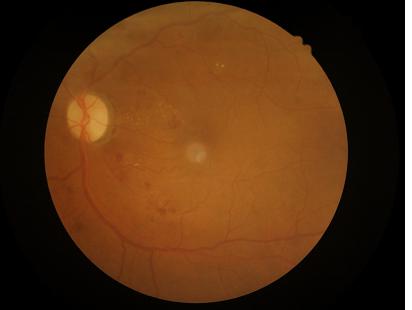

Vessels and details are readily distinguishable.
No noticeable blur.
Image quality is adequate for diagnostic use.
Even illumination with no color cast.